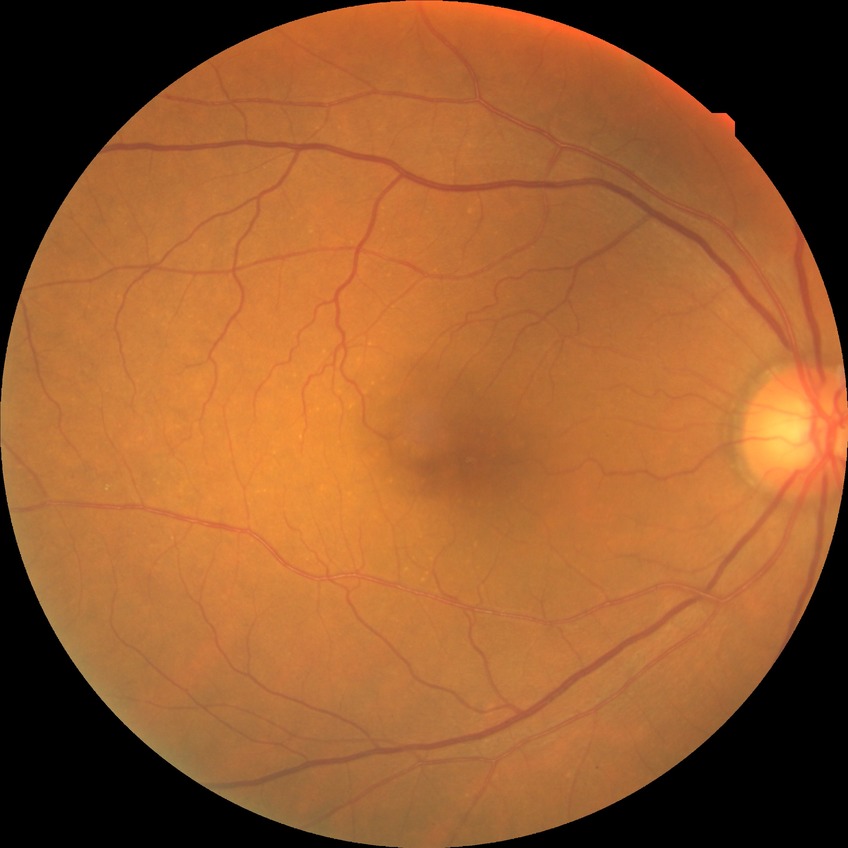

diabetic retinopathy (DR): simple diabetic retinopathy (SDR).